1659 x 2212 pixels; color fundus image: 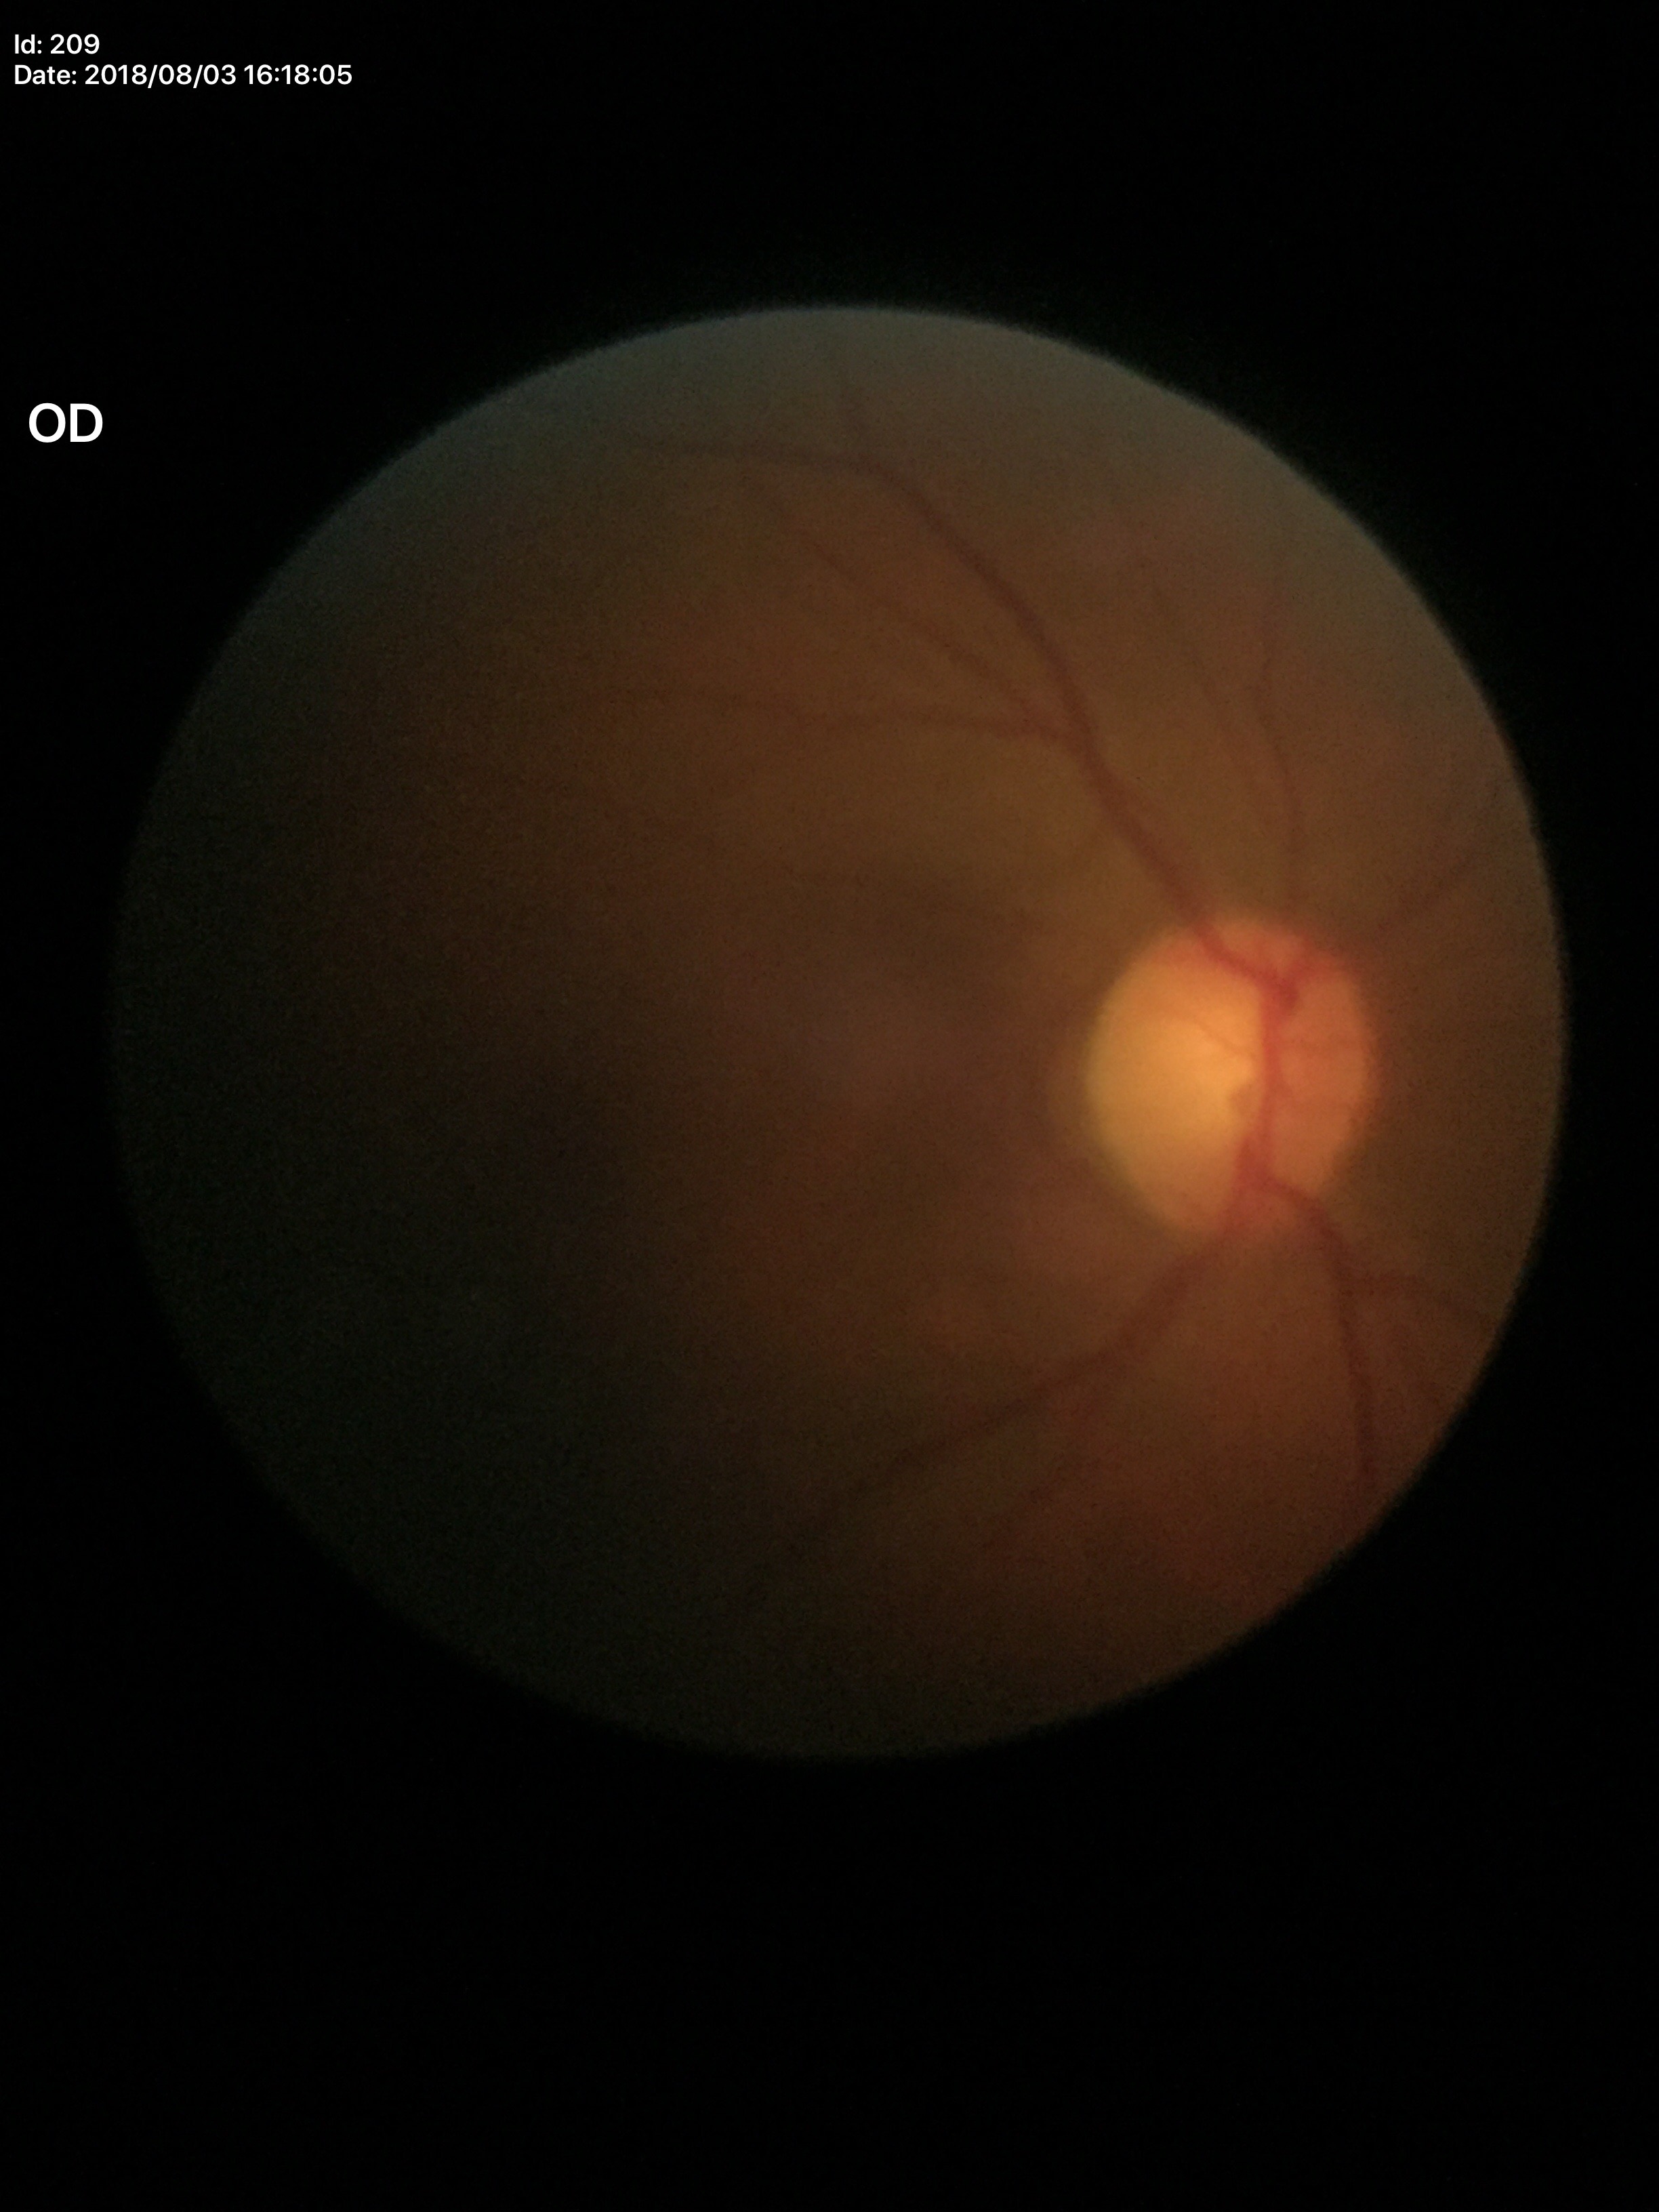
Optic disc analysis:
* Glaucoma impression · not suspect
* vertical cup-to-disc ratio (VCDR) · 0.54
* horizontal cup-disc ratio (HCDR) · 0.50